45-degree field of view, Davis DR grading, NIDEK AFC-230 fundus camera.
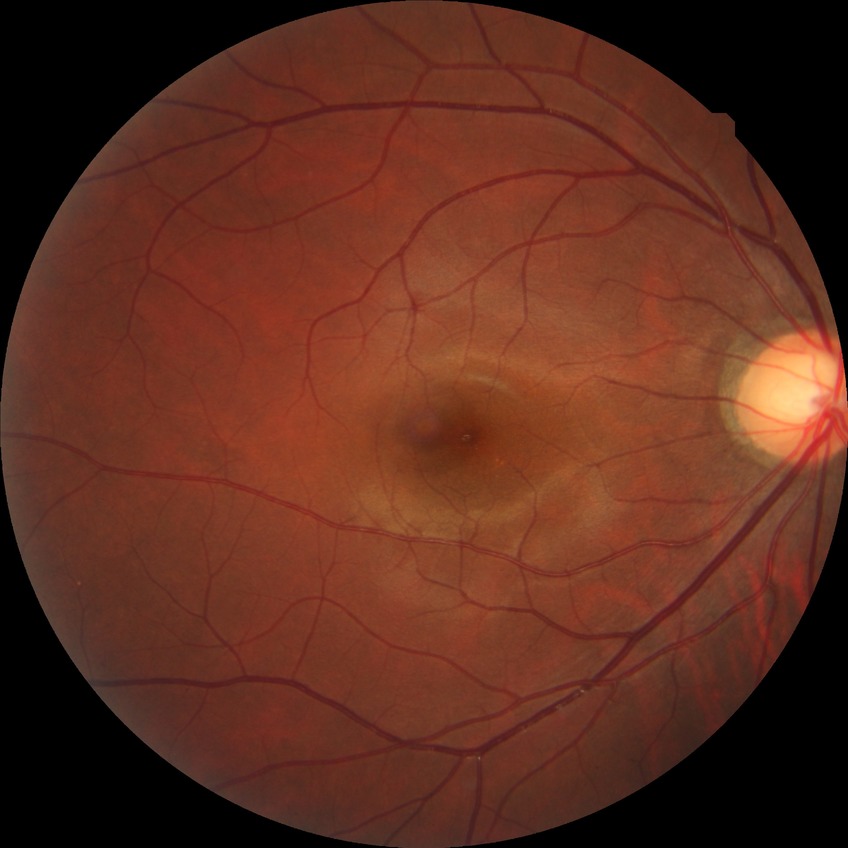
Modified Davis grade: NDR.